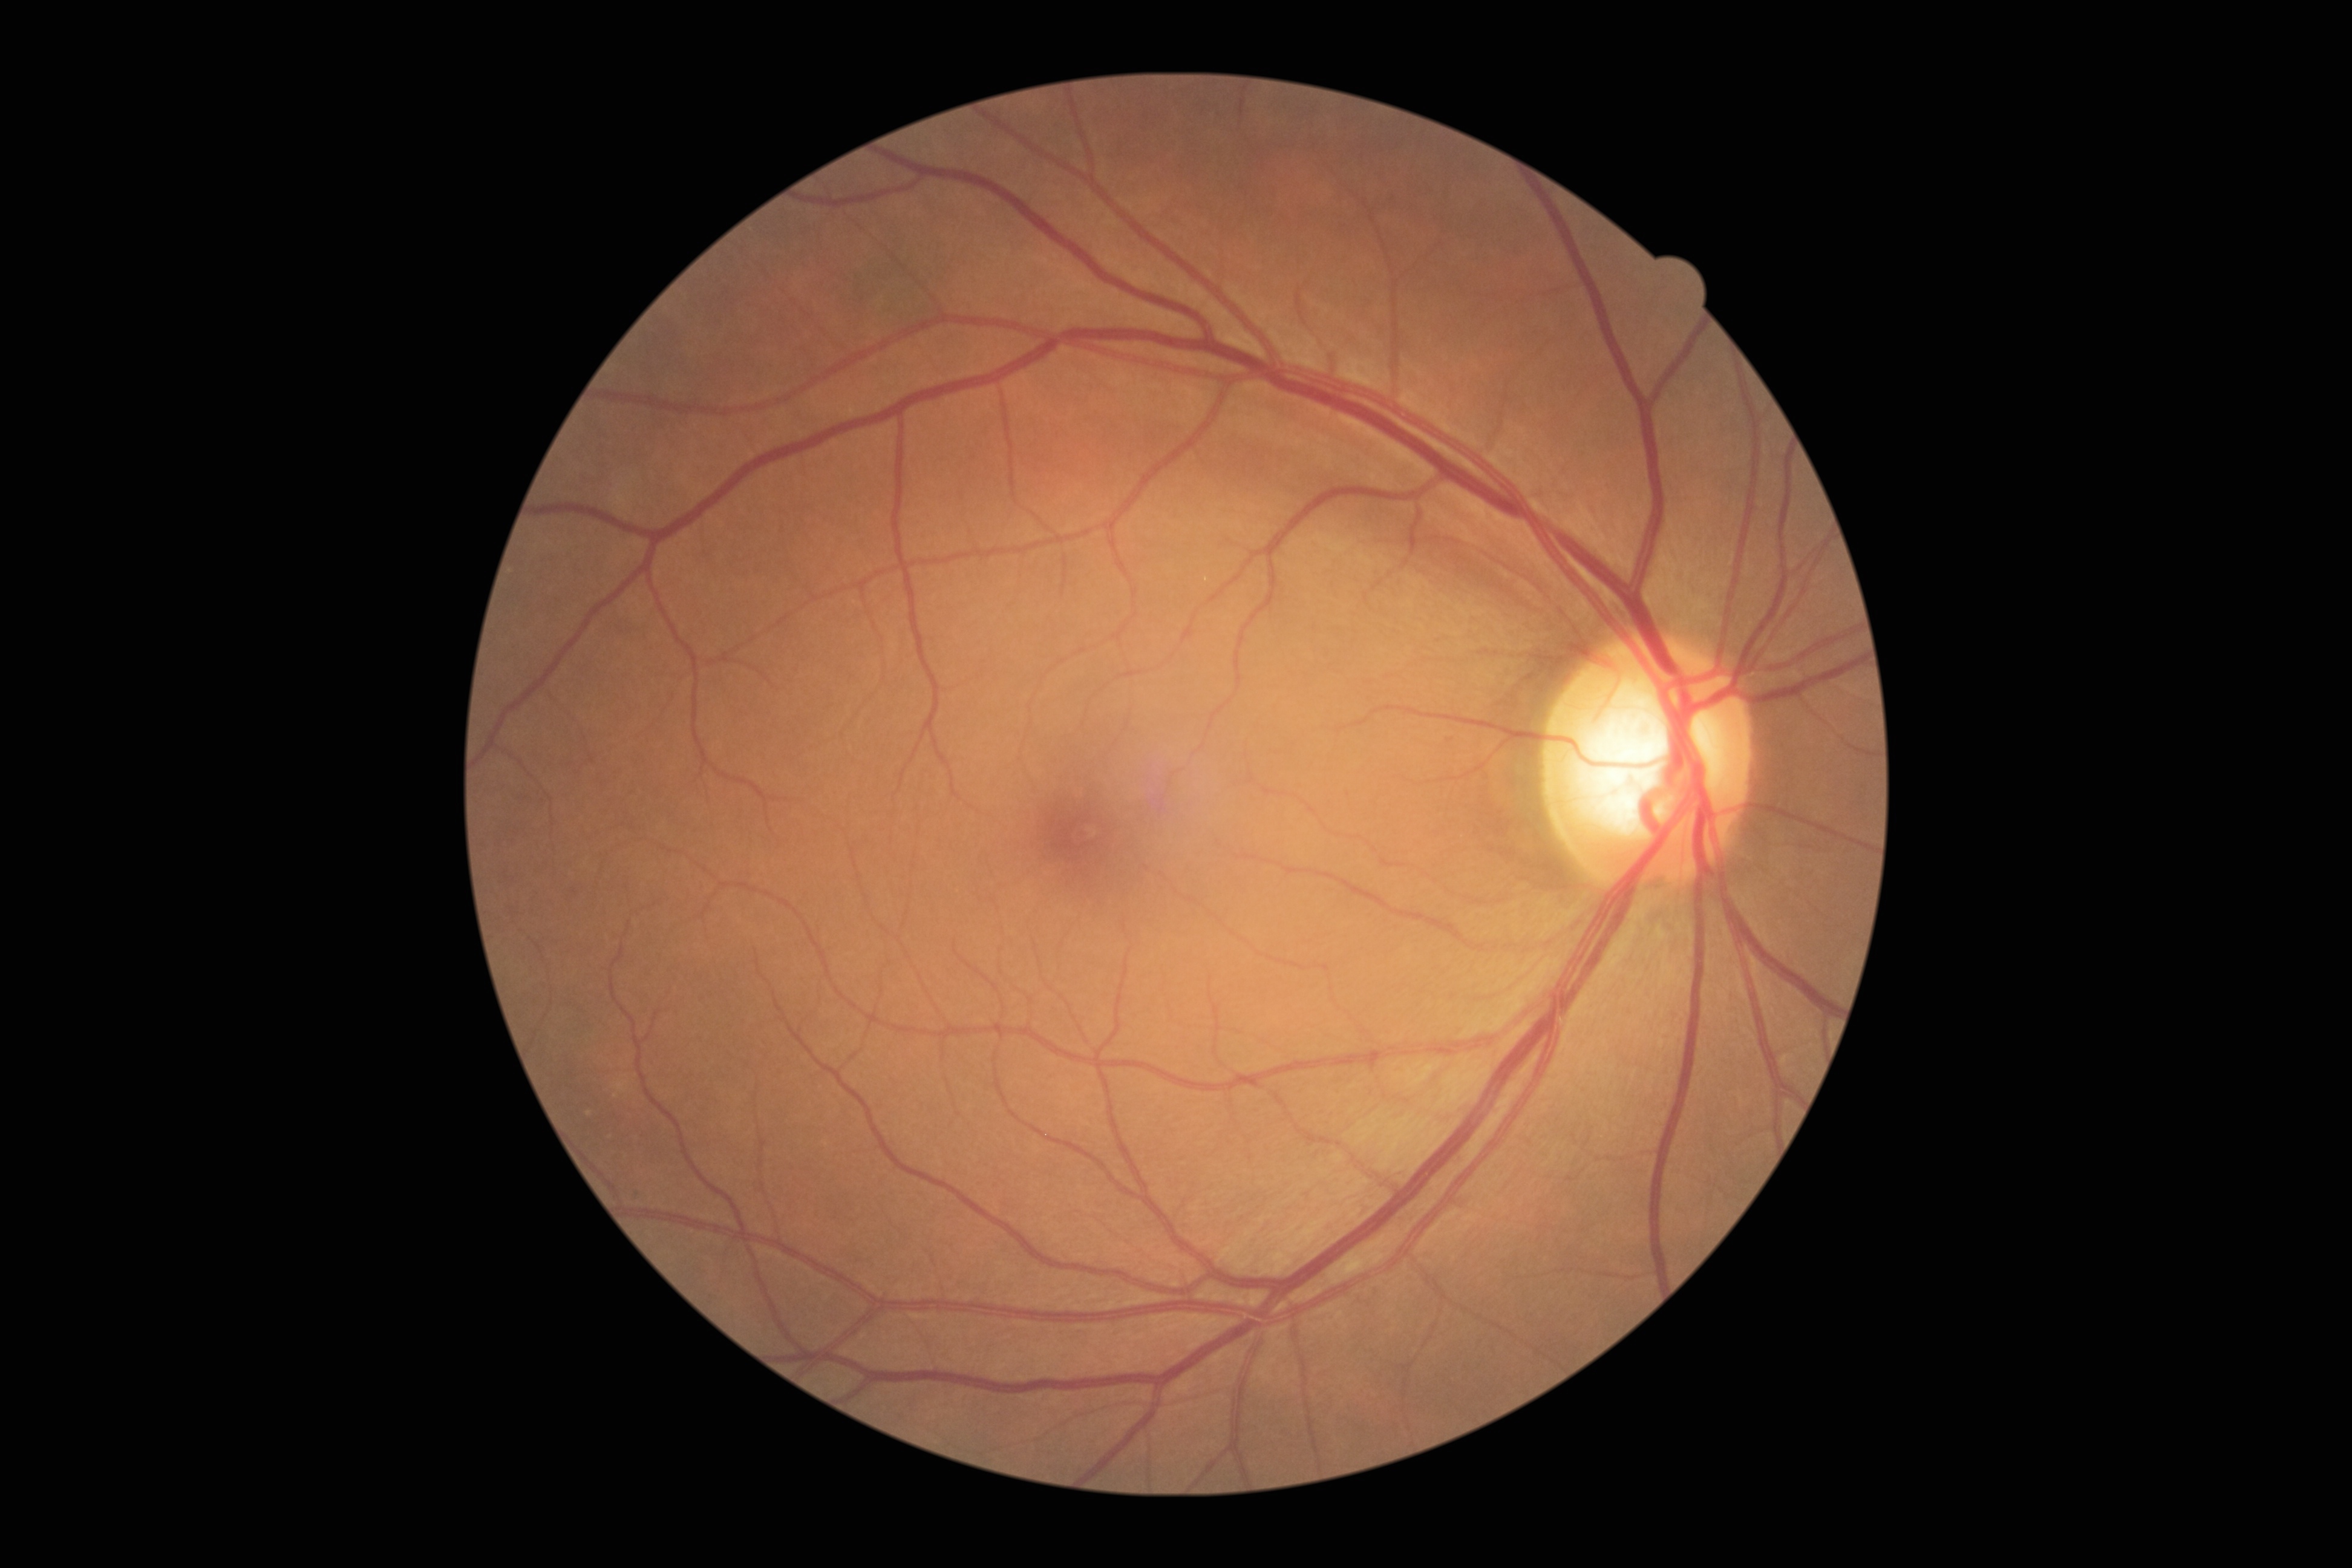

Retinopathy is no apparent diabetic retinopathy (grade 0).